45° FOV:
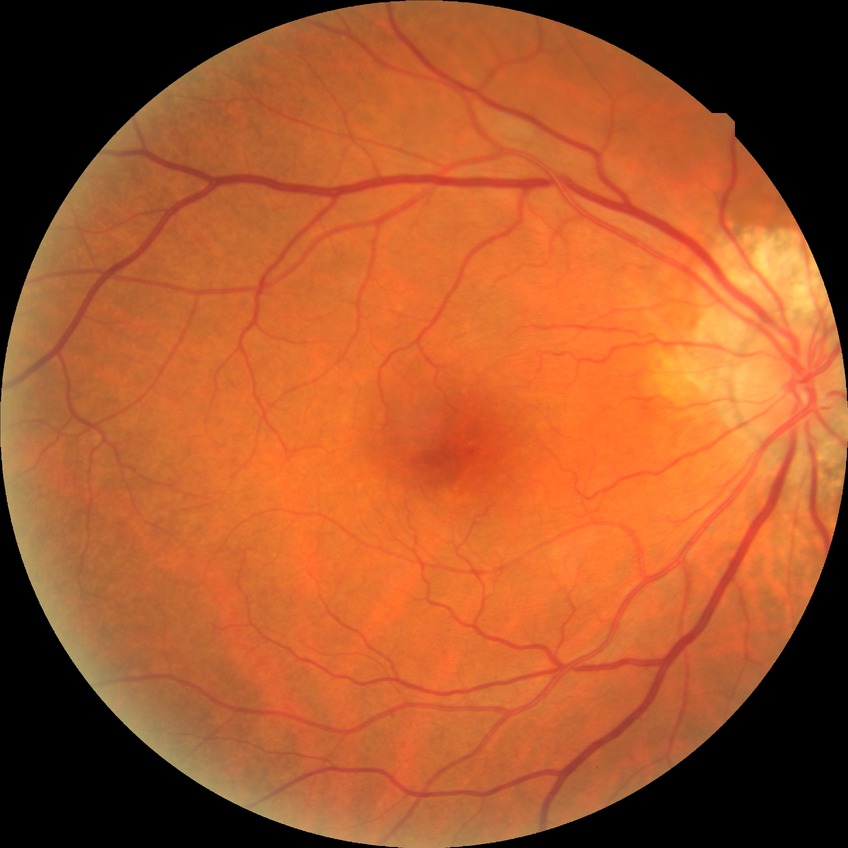
Diabetic retinopathy stage: no diabetic retinopathy.